45° field of view: 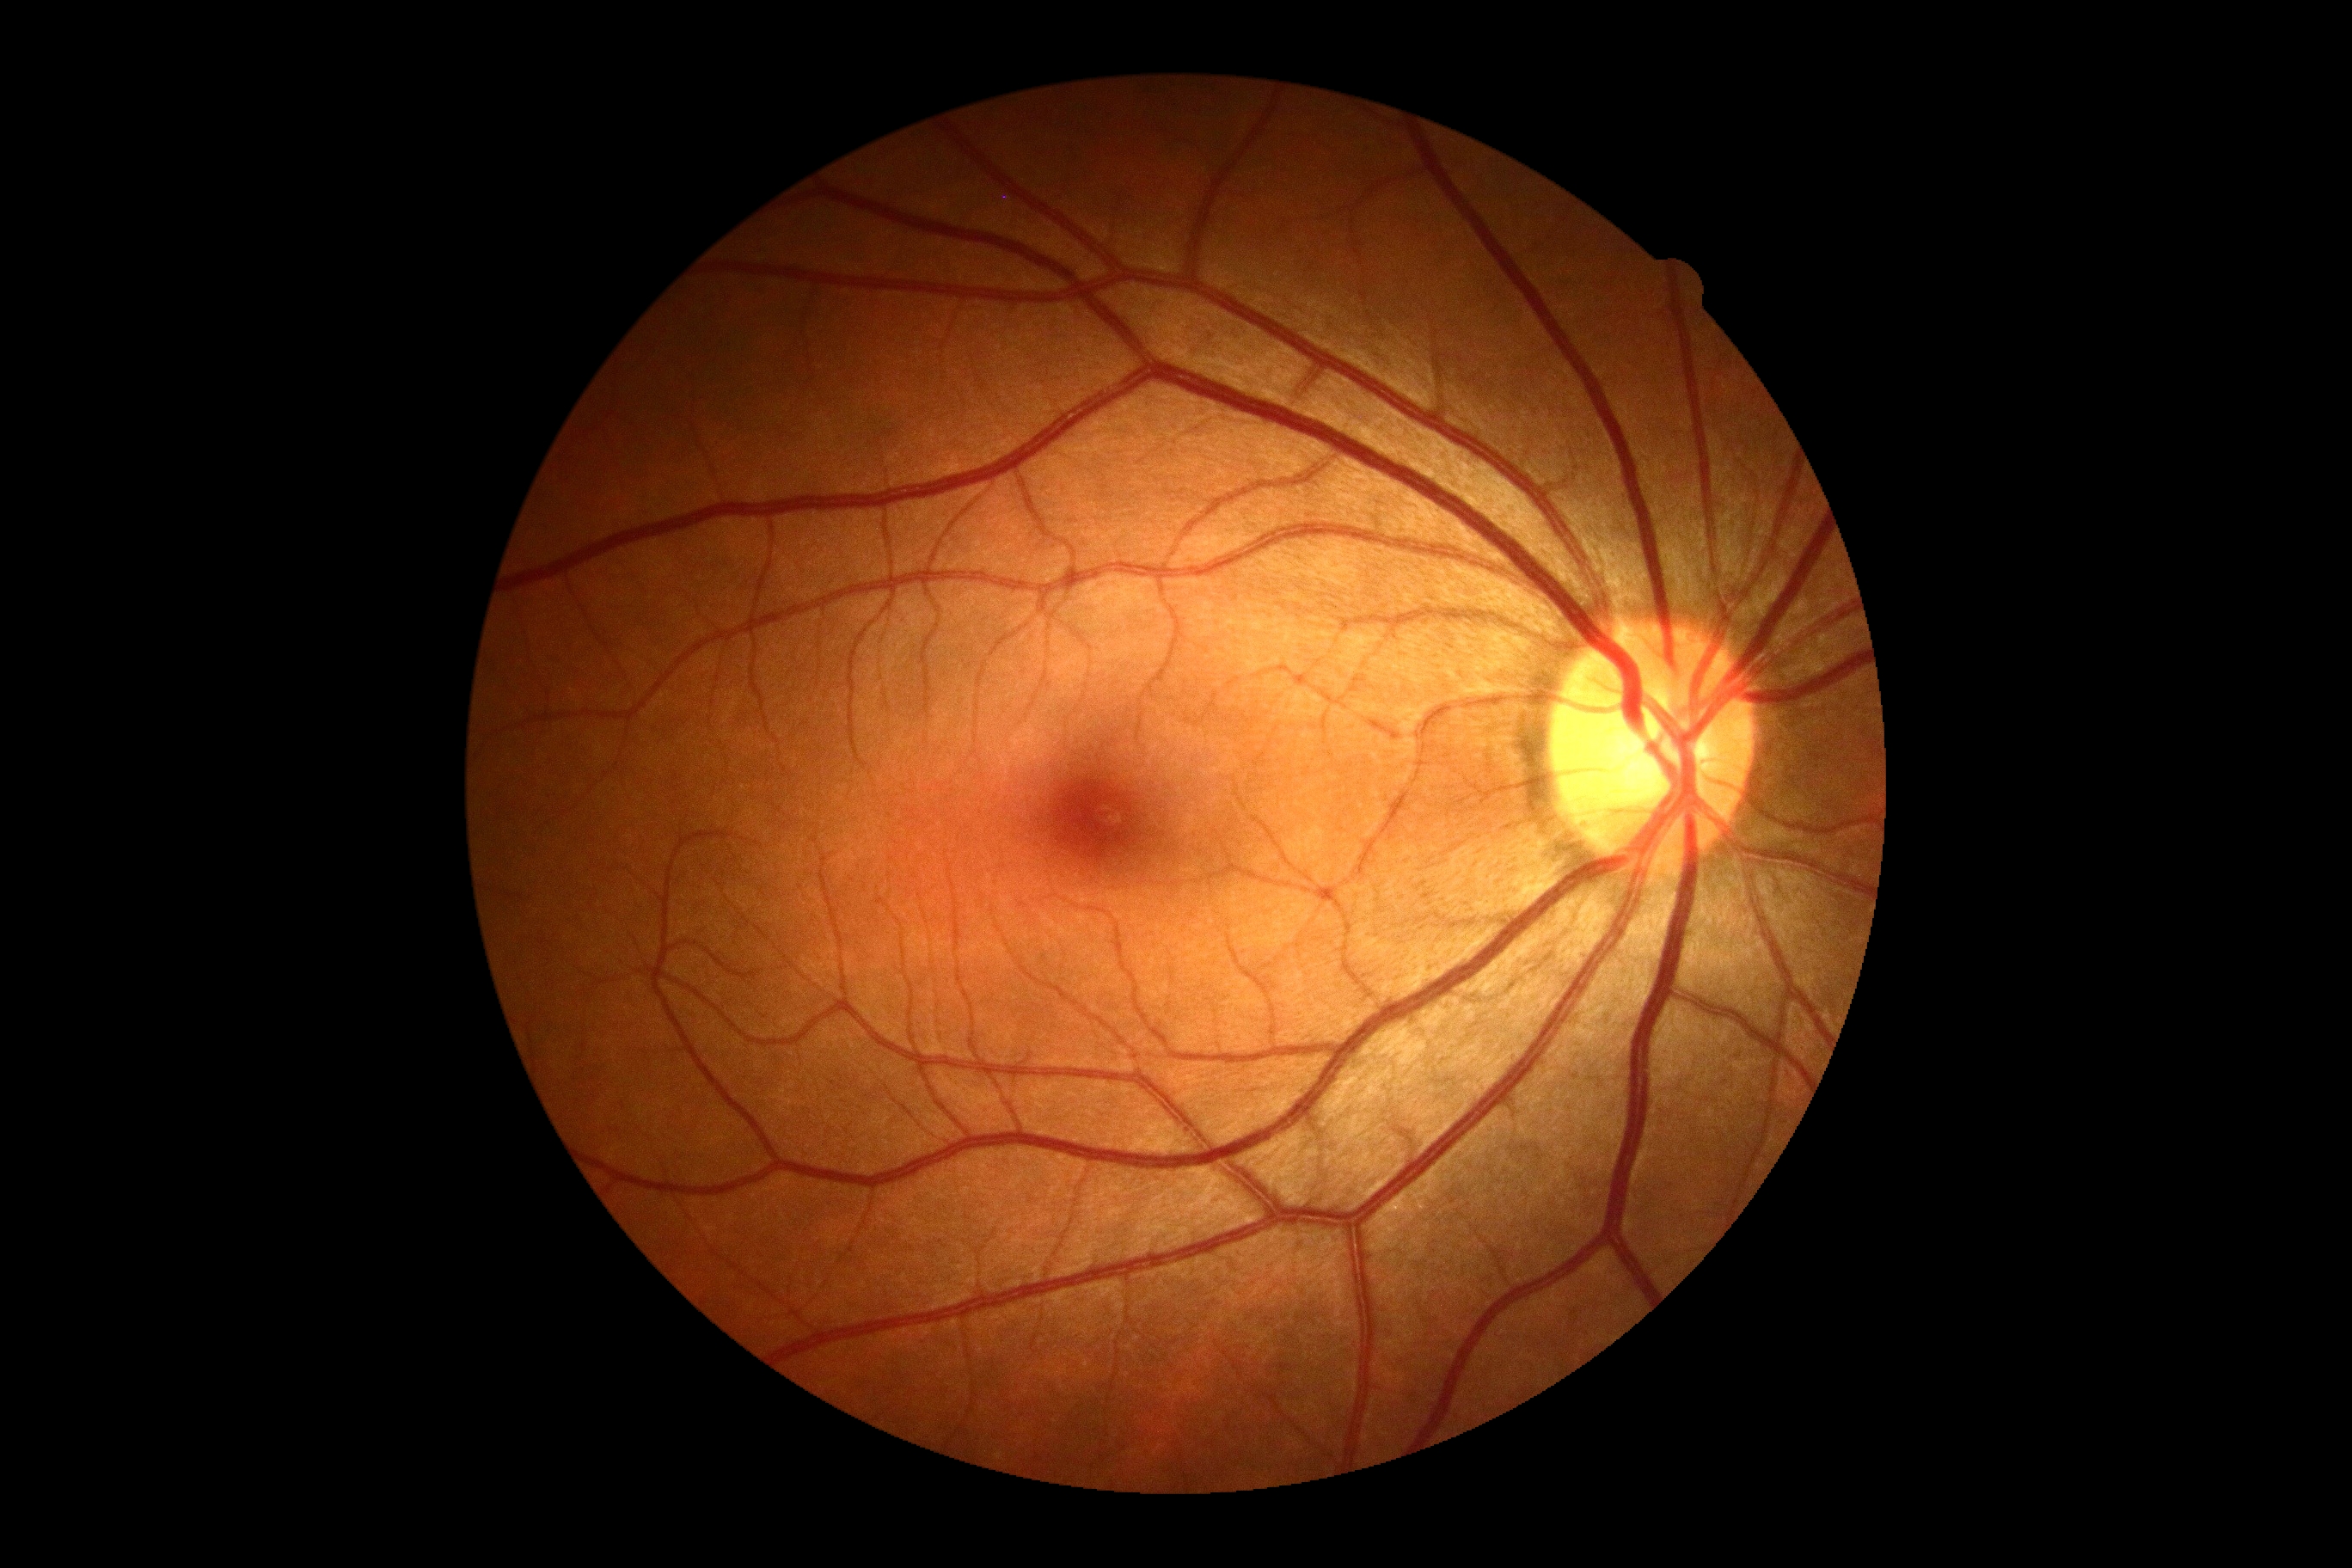

Diabetic retinopathy (DR) is 0/4.